Image size 2184x1690. FOV: 45 degrees. Color fundus image.
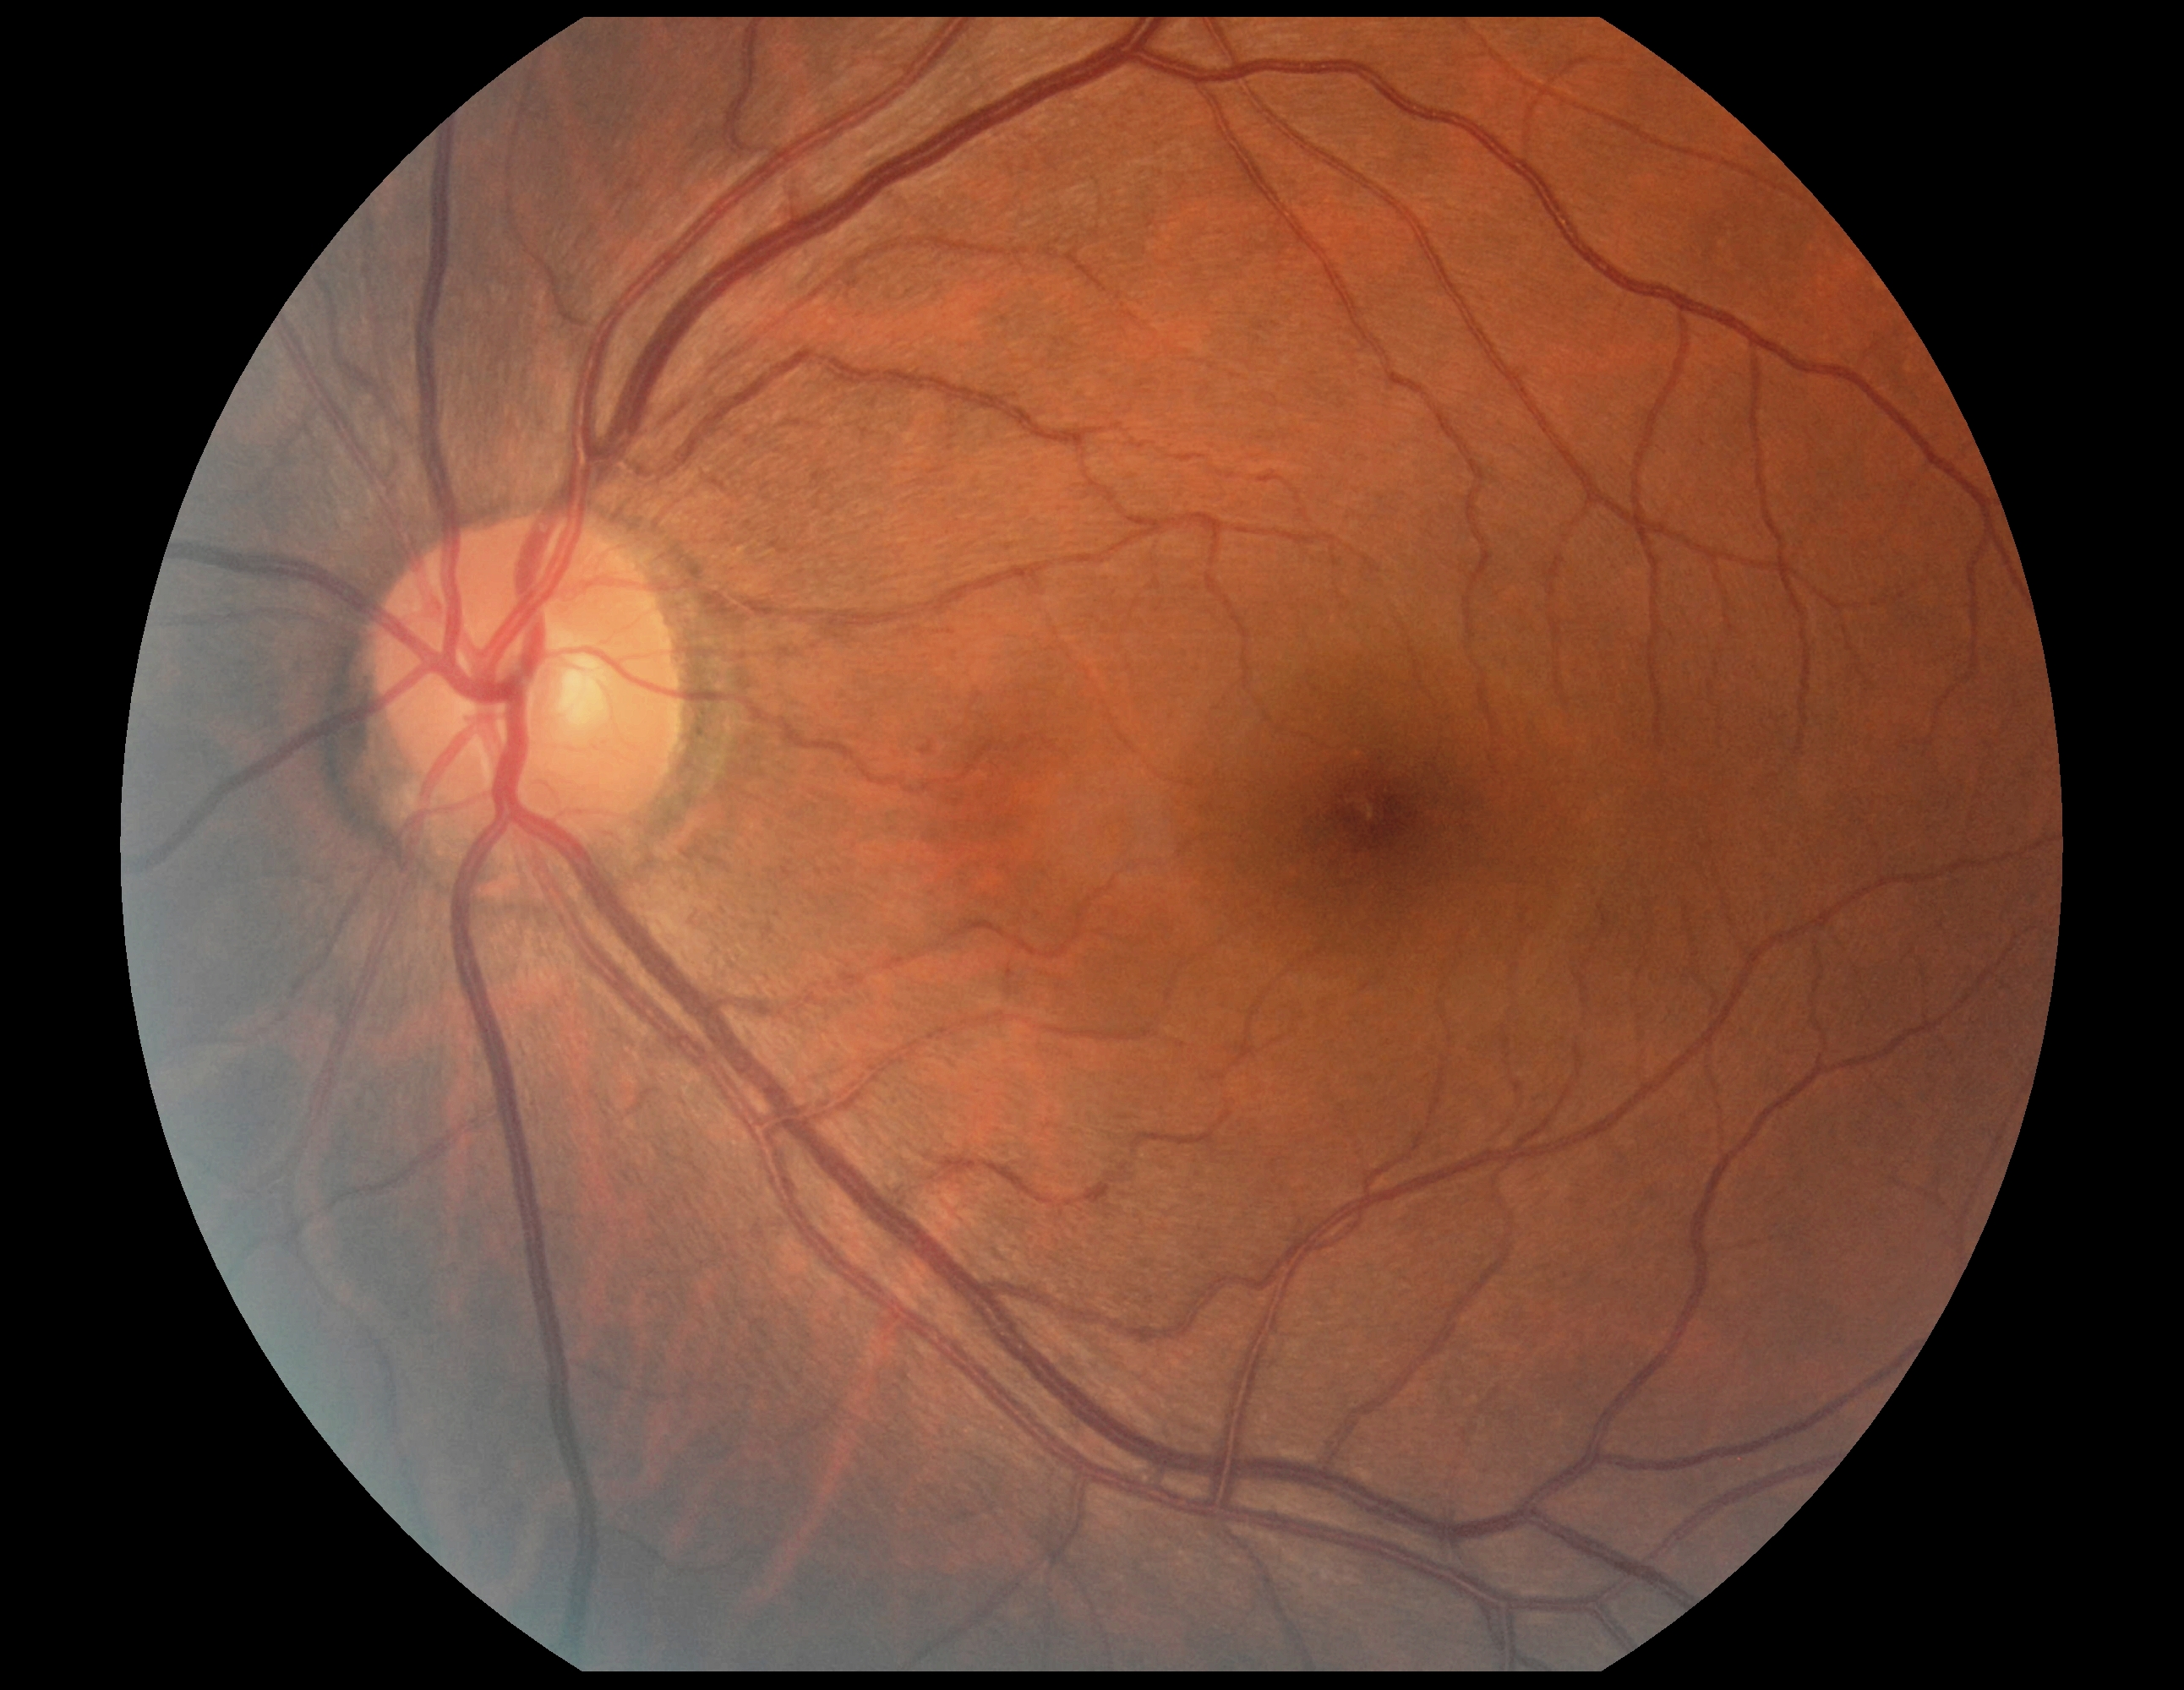 • diabetic retinopathy (DR) — grade 0 (no apparent retinopathy)